Infant wide-field retinal image — 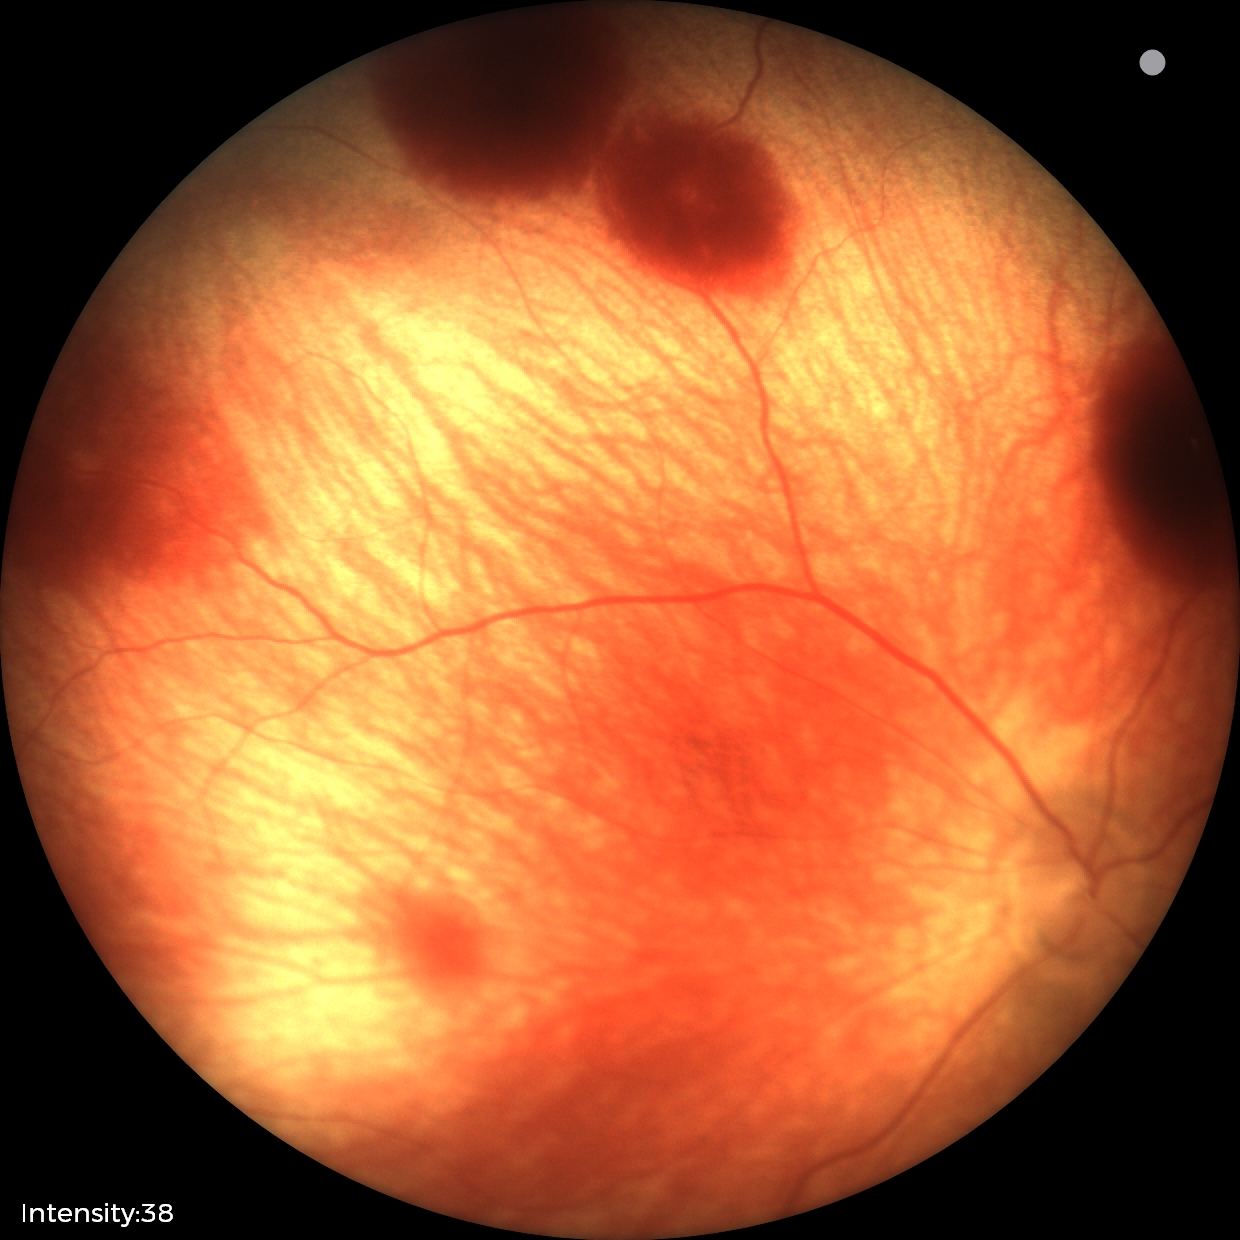
From an examination with diagnosis of retinal hemorrhages.